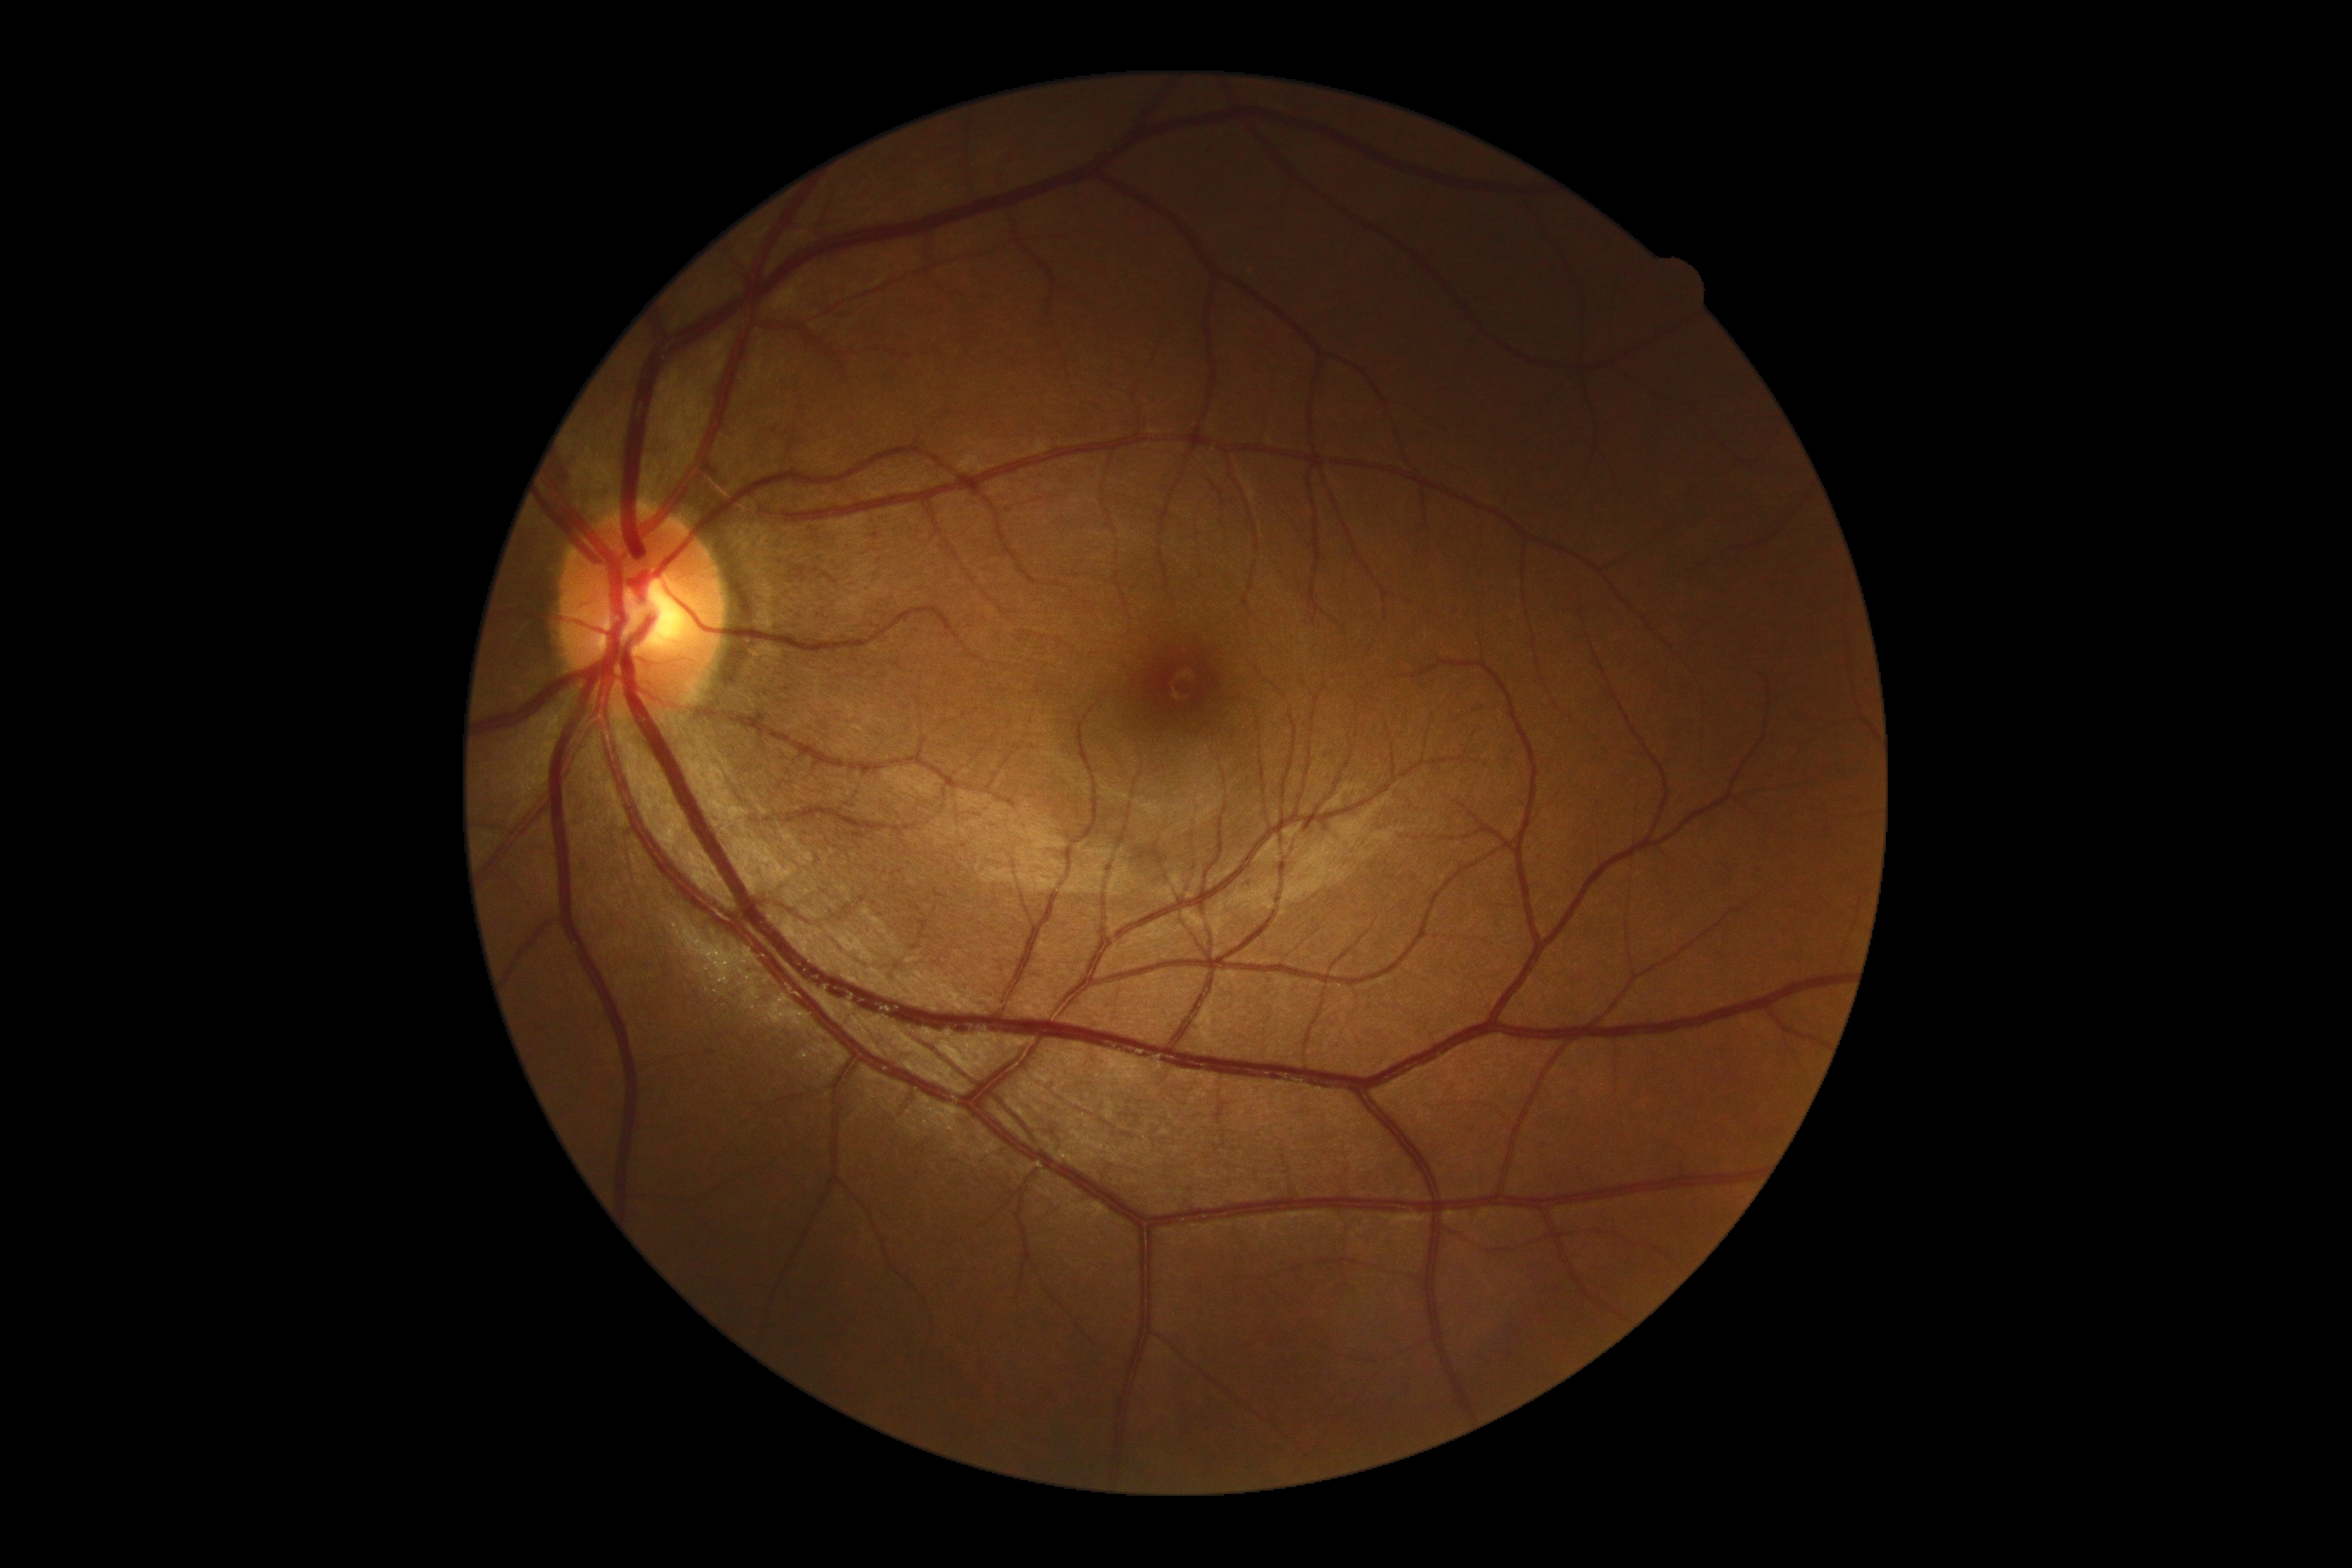

DR stage: 0.